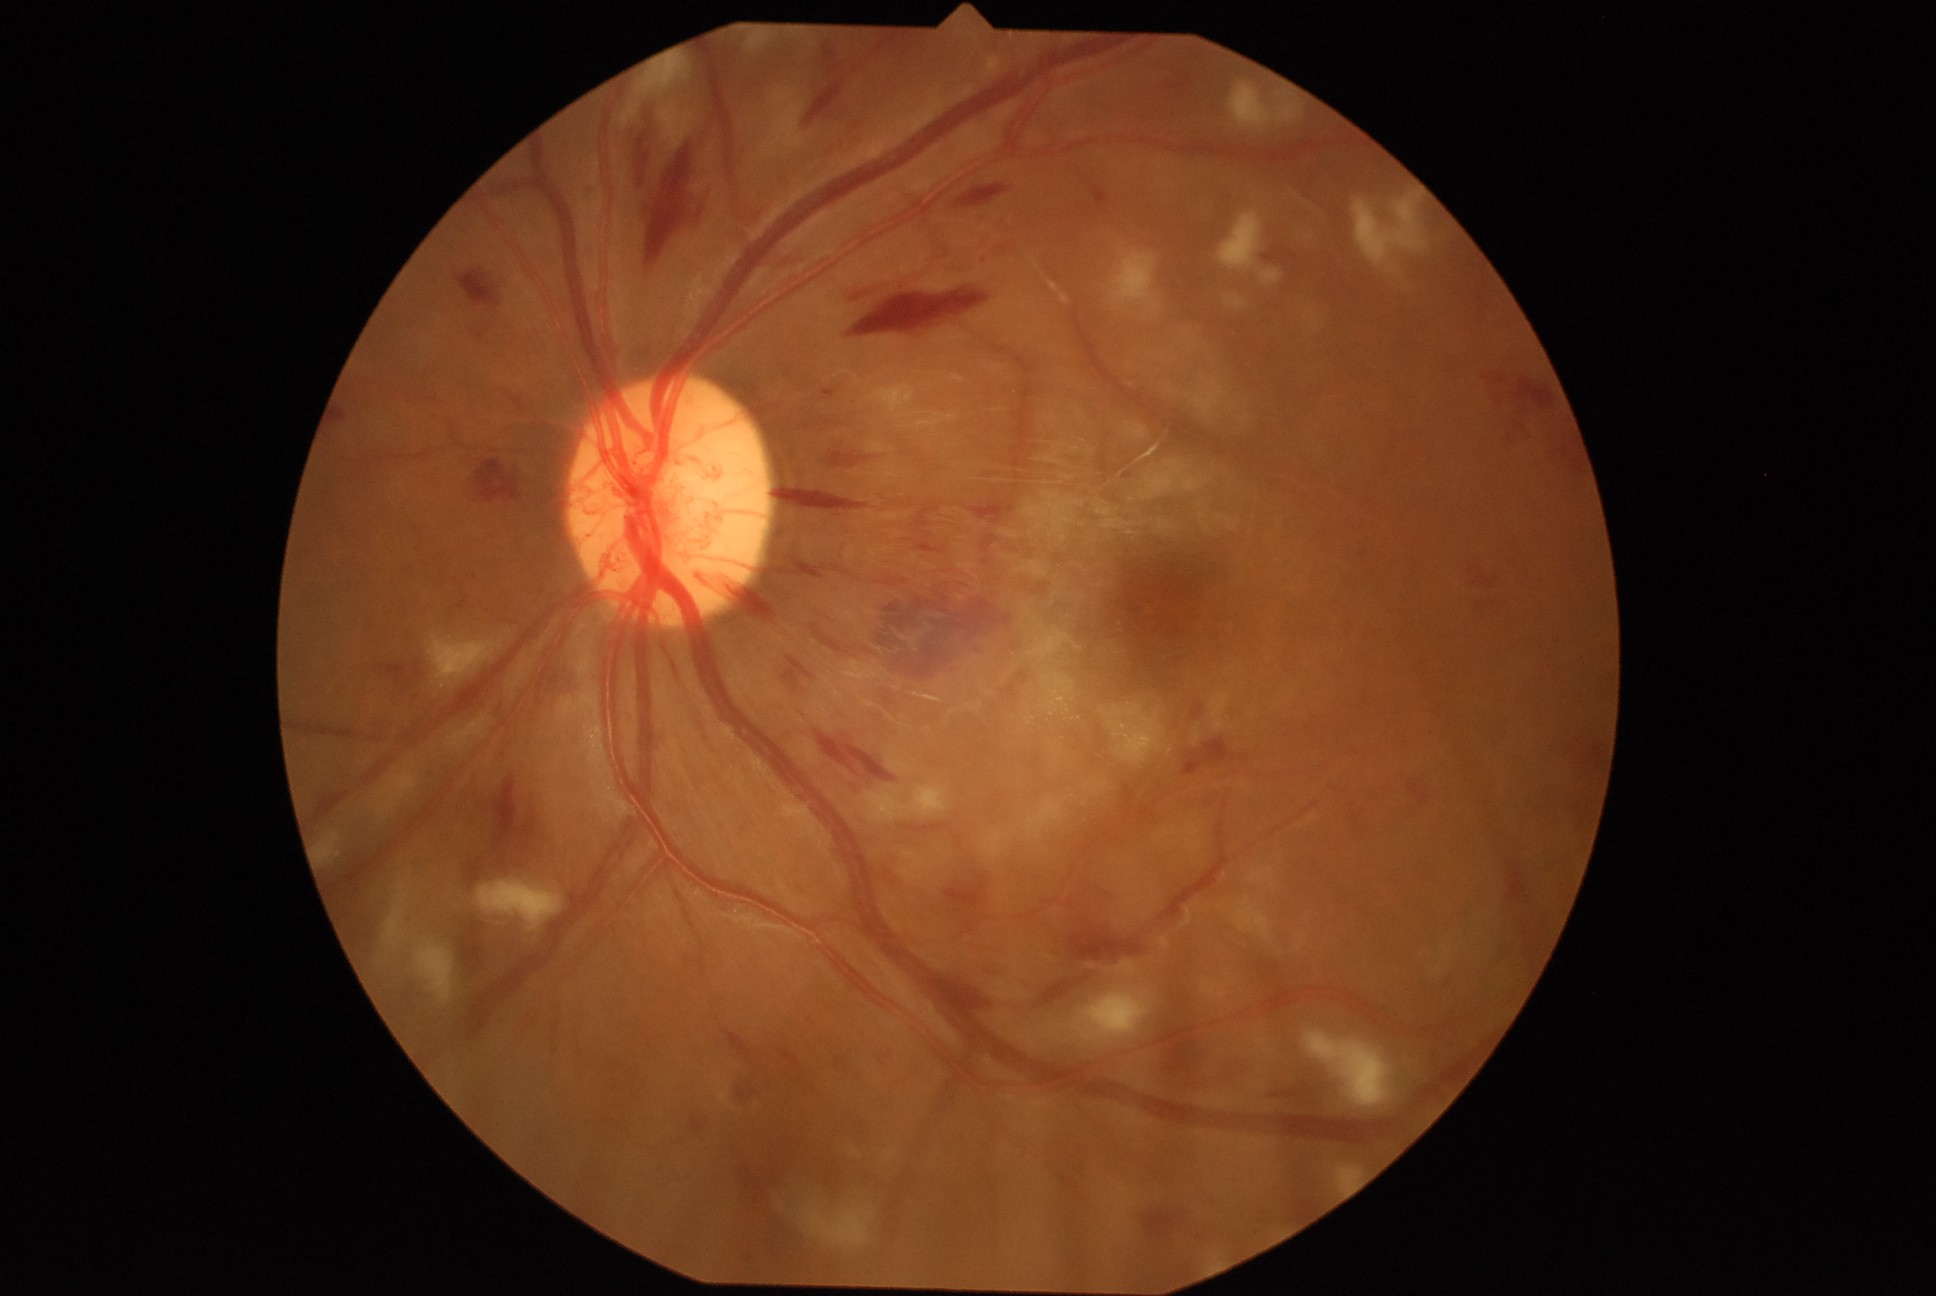
Diabetic retinopathy (DR) is grade 4 (PDR)
A subset of detected lesions:
soft exudates (SEs) (partial) = 1192/380/1226/416; 429/636/503/689; 1262/270/1281/284; 1113/253/1159/312; 1183/476/1201/492; 1106/703/1164/766; 916/781/943/815; 1218/212/1263/270; 1276/107/1297/124; 1352/189/1426/266; 1230/84/1272/129; 1334/1166/1364/1194; 385/874/414/948; 1143/461/1187/501
hemorrhages (HEs) (partial) = 748/1179/765/1195; 929/975/991/1018; 792/561/821/577; 904/824/962/848; 1486/373/1495/380; 1192/702/1205/718; 1494/376/1505/384; 412/664/421/678; 689/1116/708/1134; 878/34/909/52; 783/656/816/691; 850/283/987/339; 717/582/779/617; 1183/741/1230/775; 1058/1173/1079/1192; 694/188/711/228; 1143/1212/1177/1237